45-degree field of view.
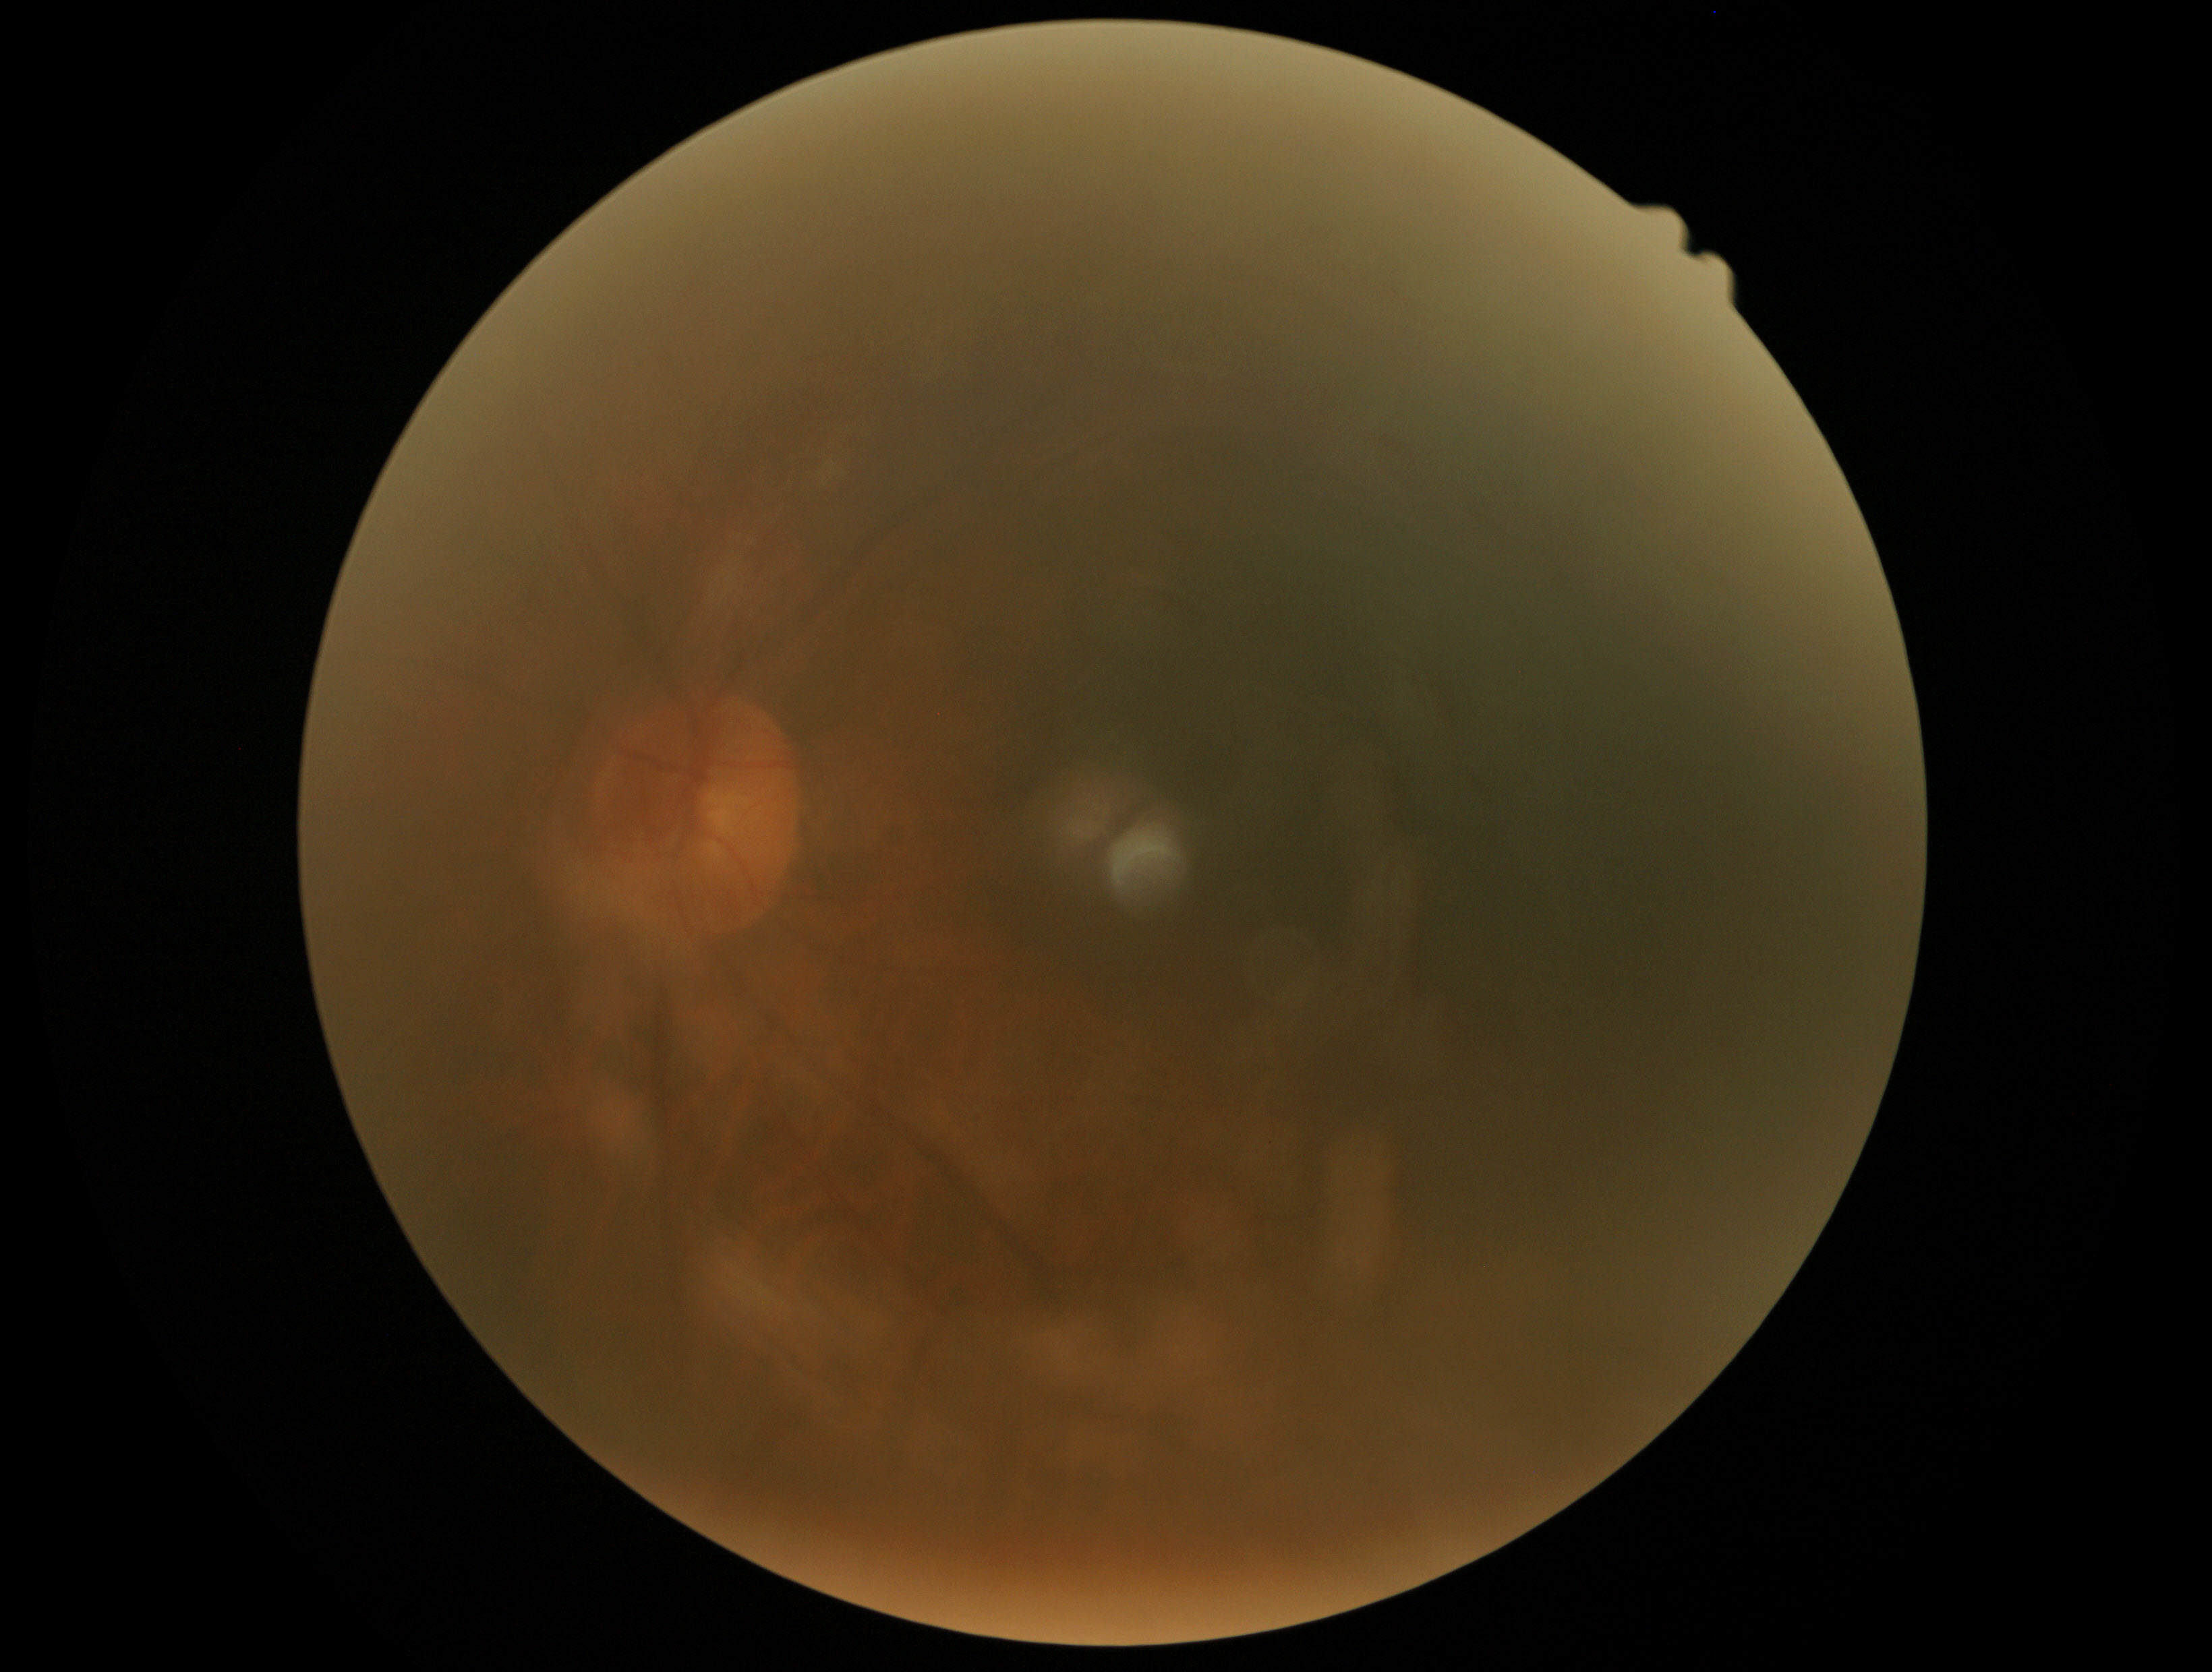
Annotations:
• DR grade — ungradable